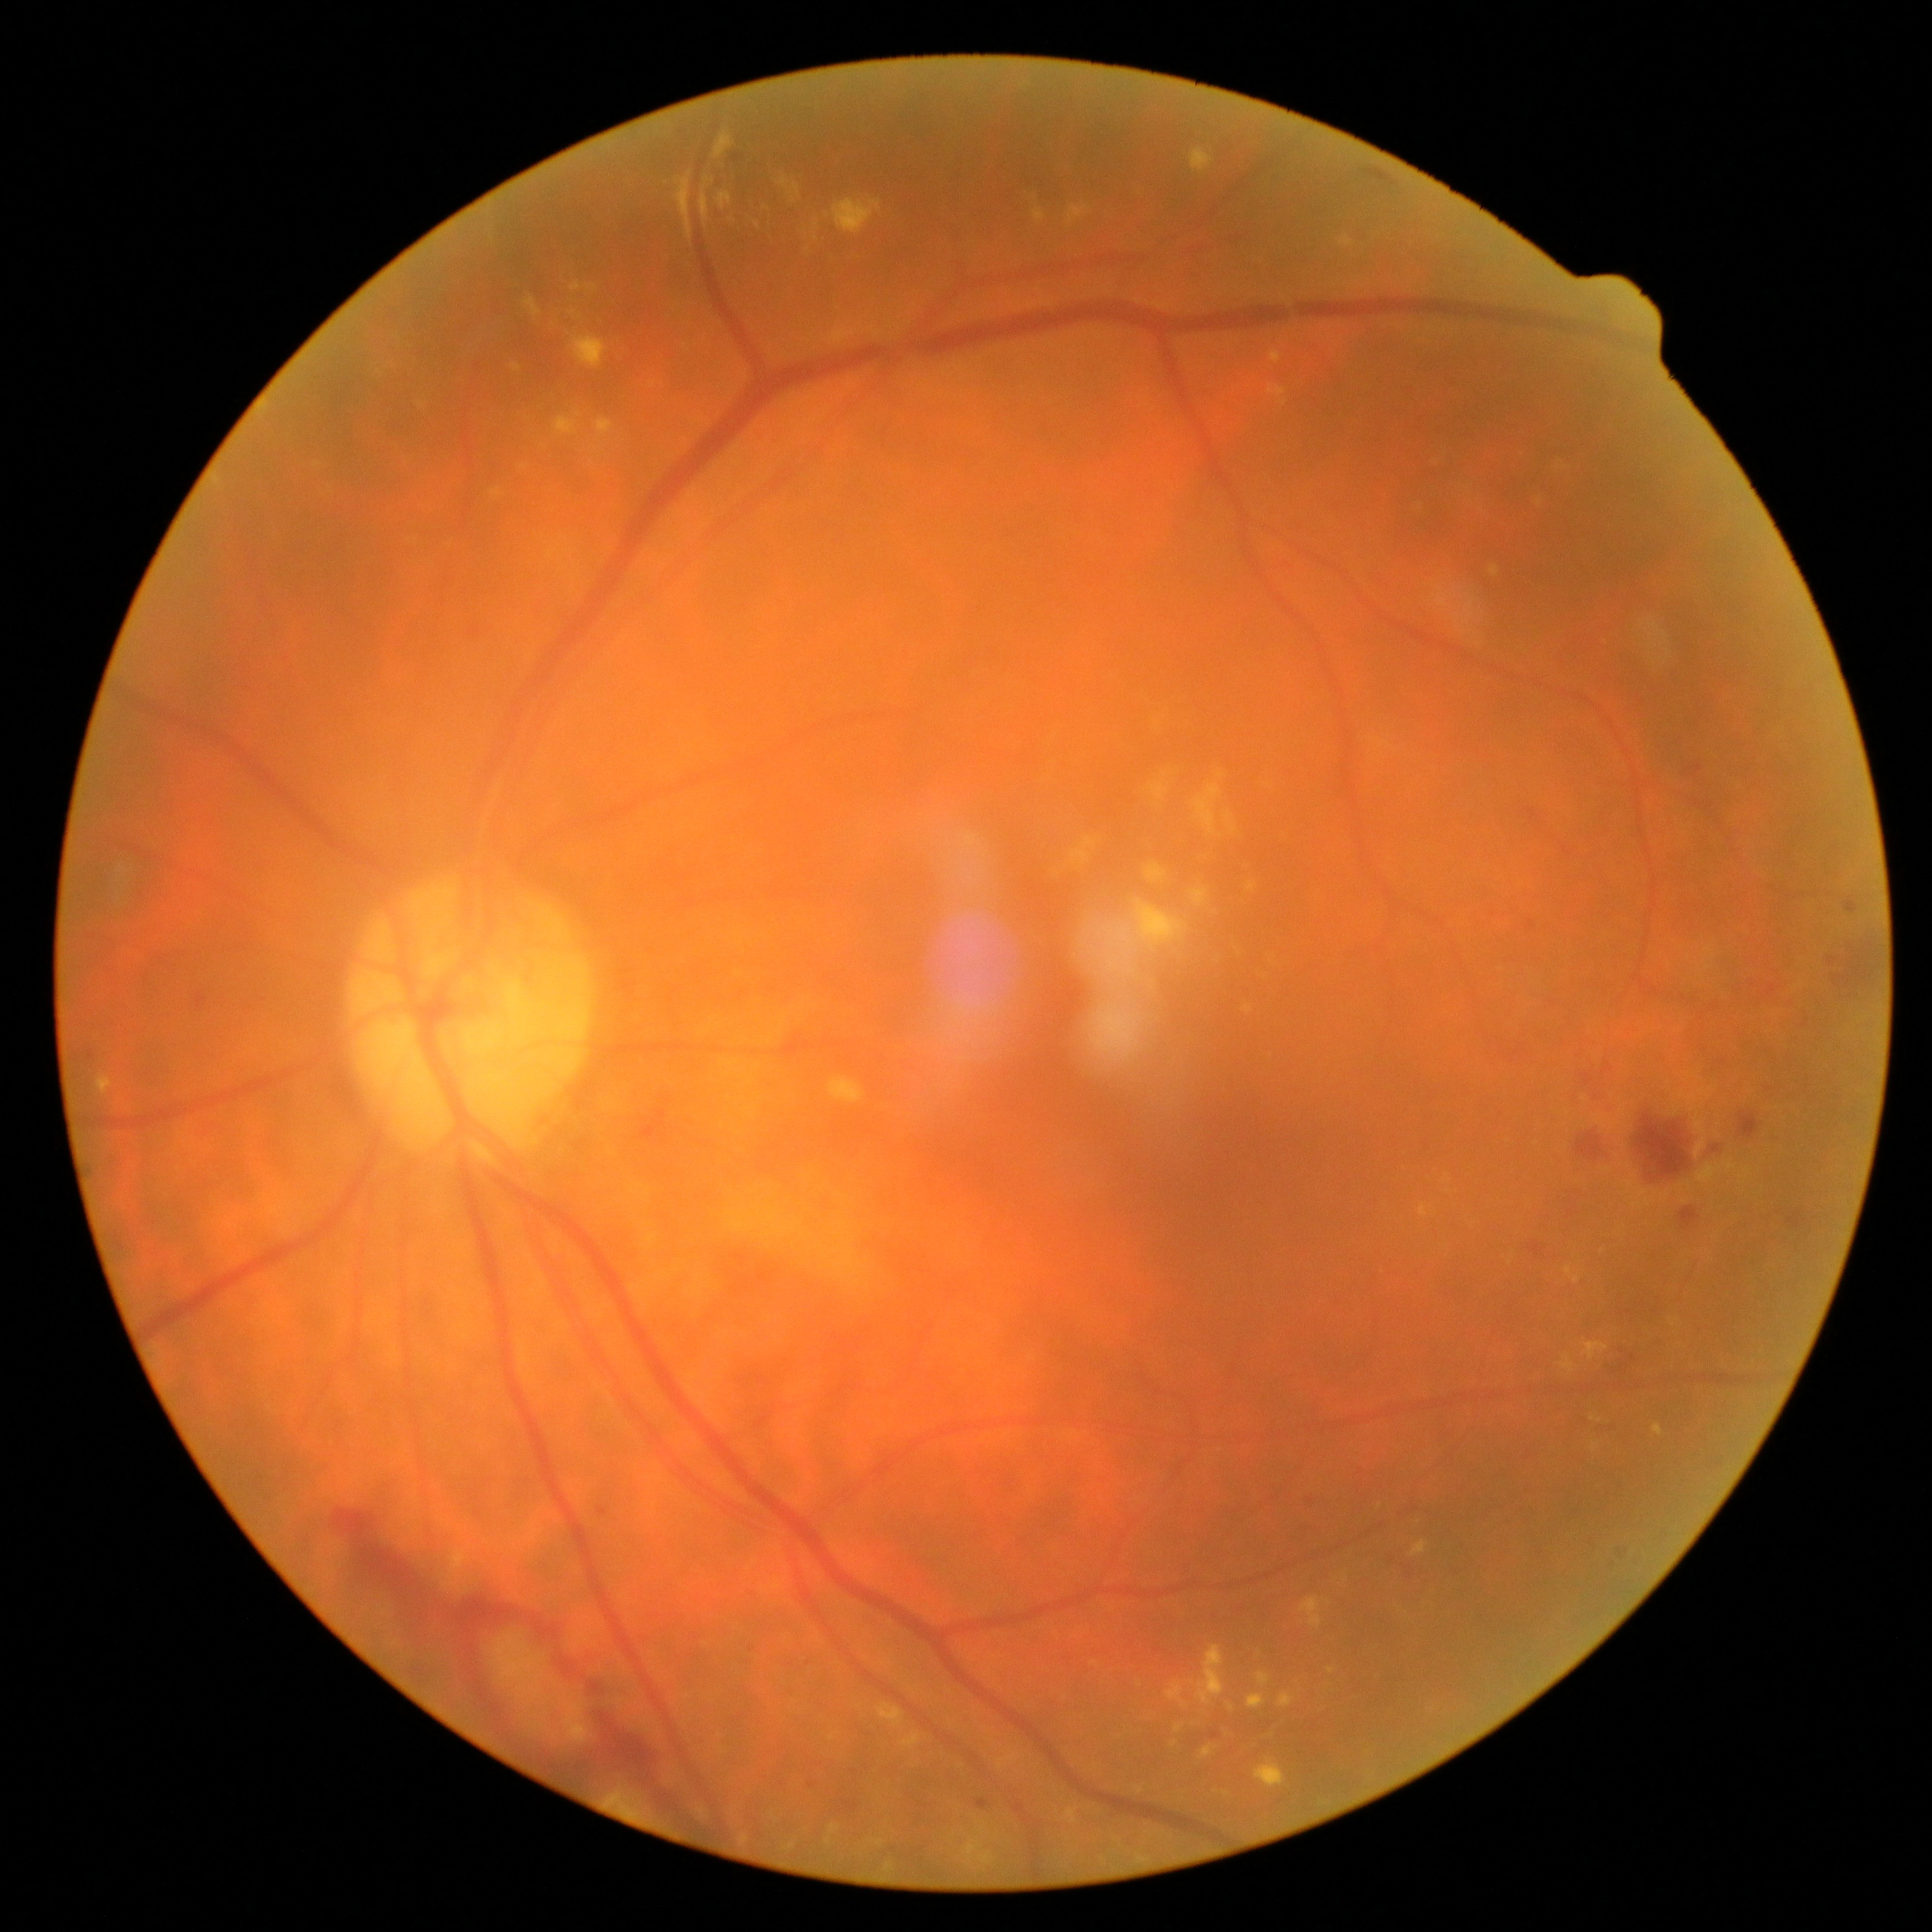
{
  "dr_category": "non-proliferative diabetic retinopathy",
  "dr_grade": "2/4"
}